FOV: 60 degrees · fundus photo taken with a portable handheld camera:
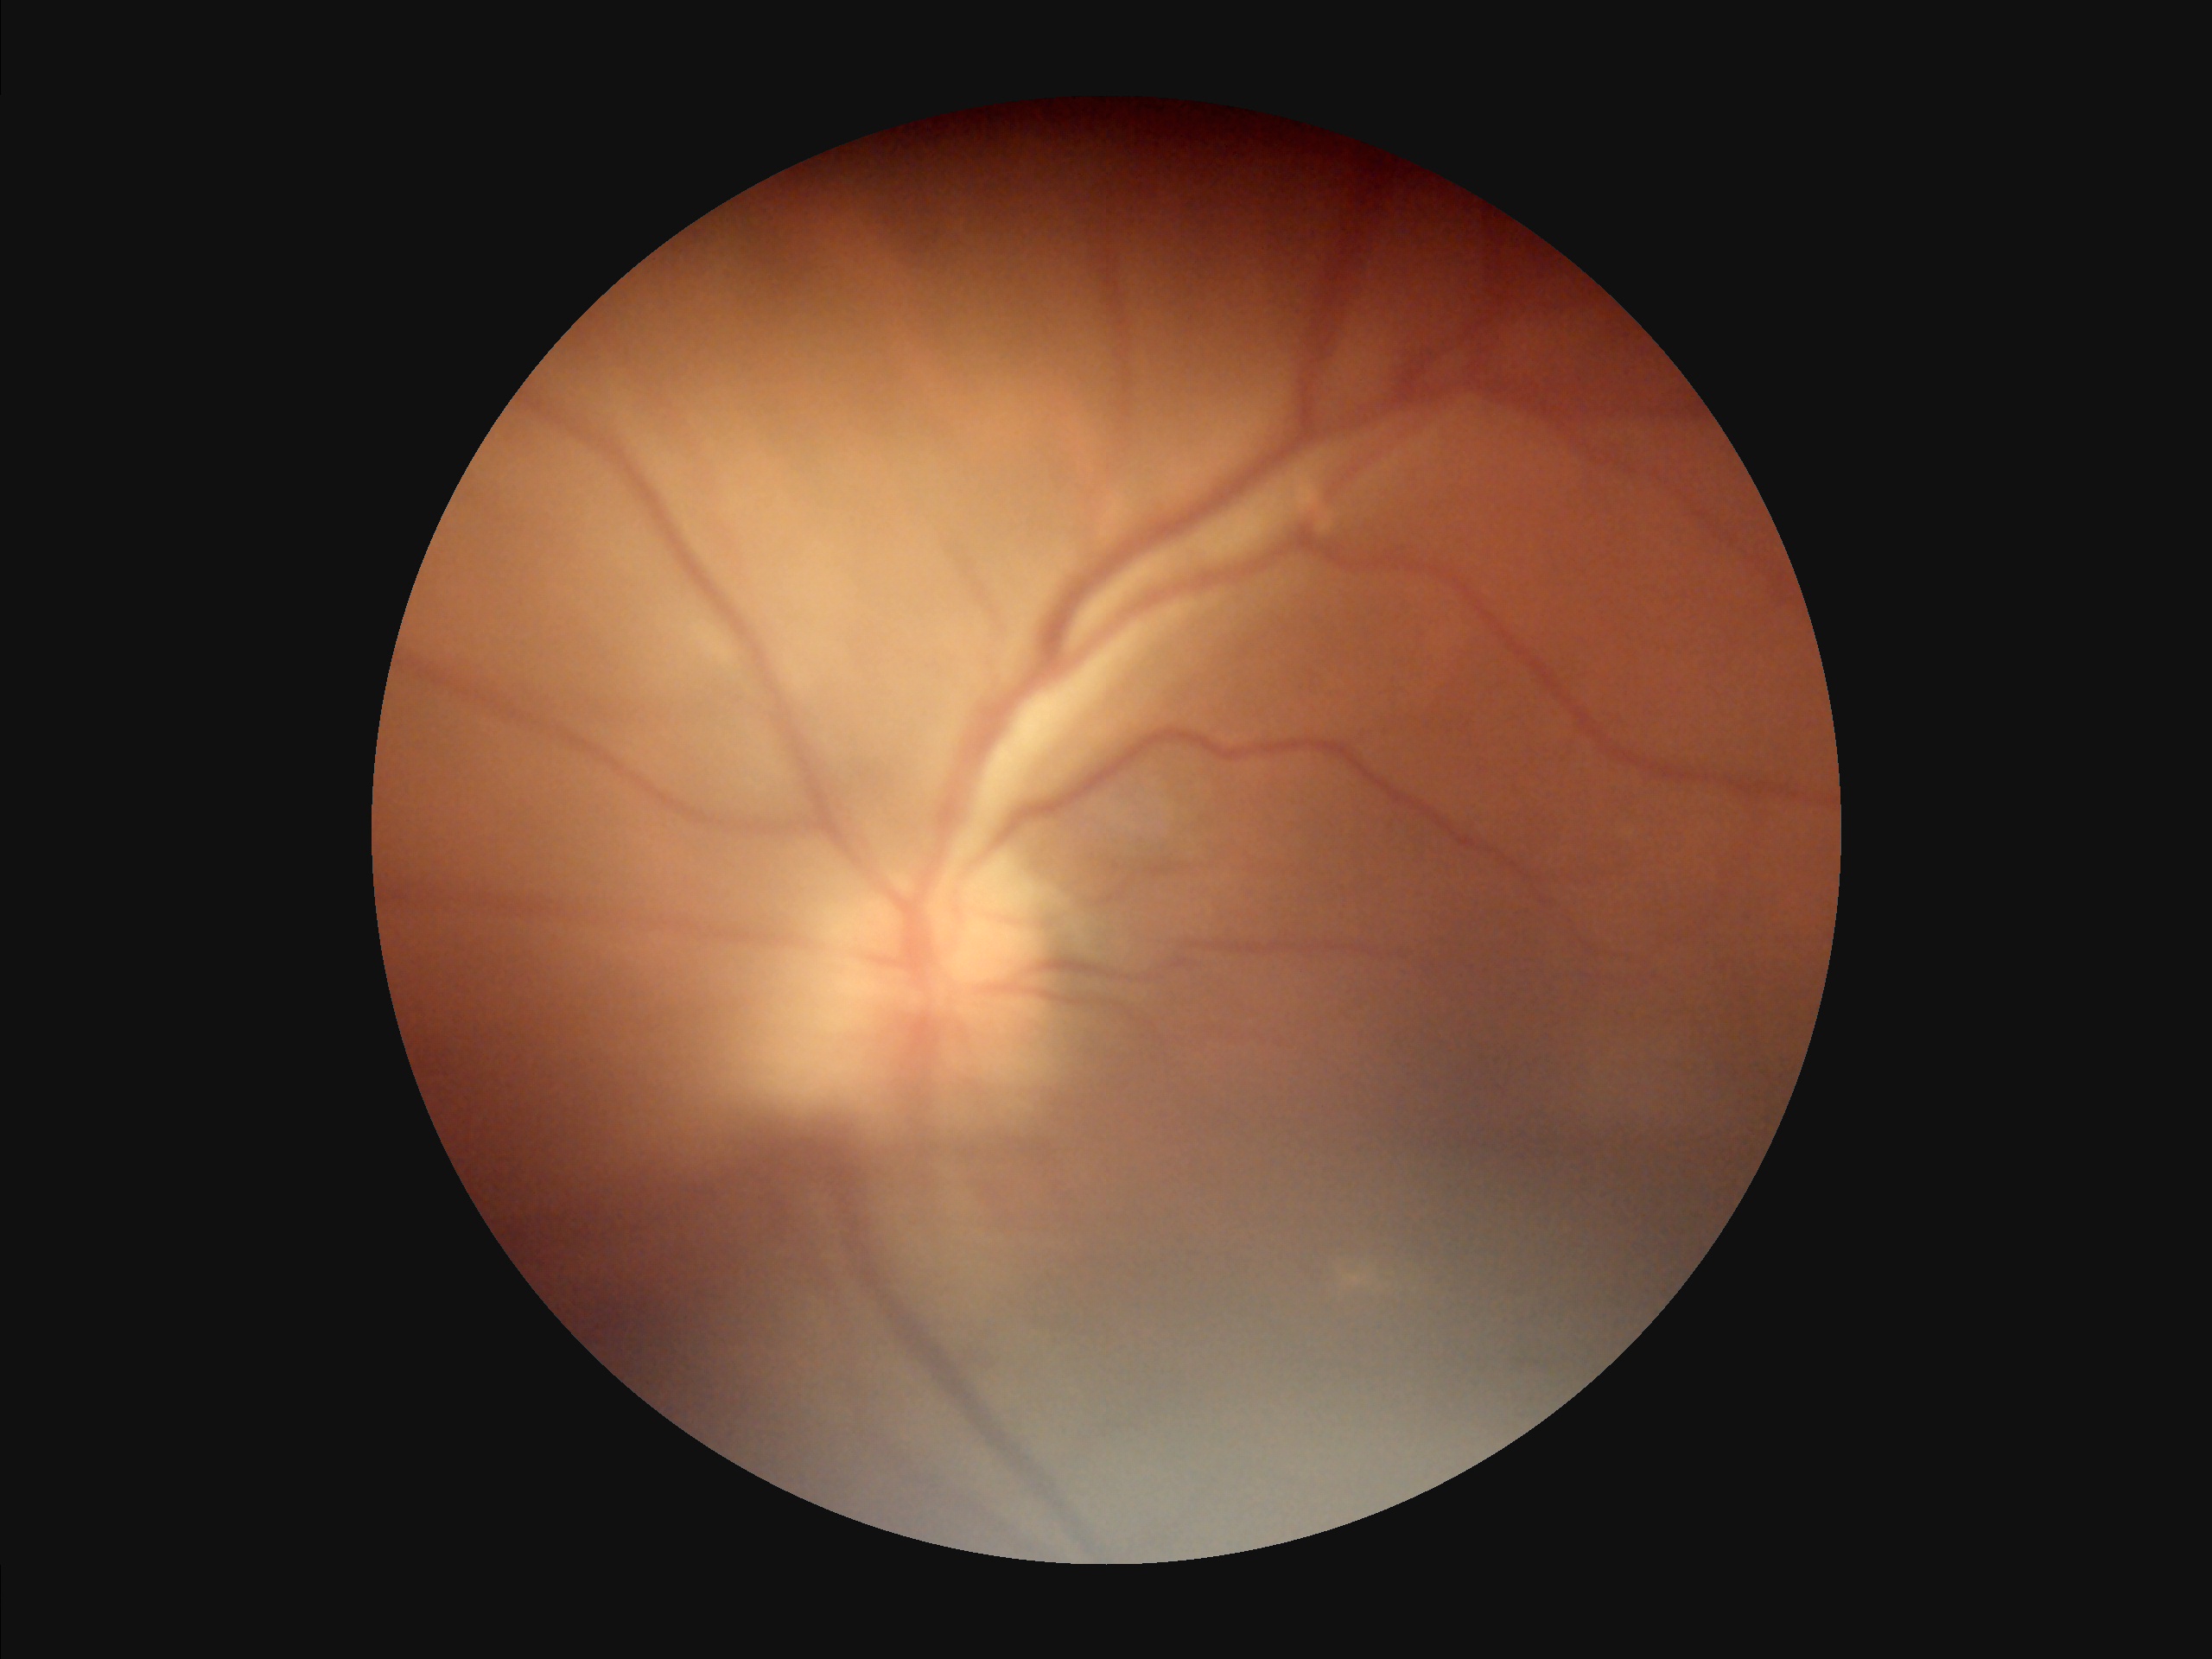

Illumination and color balance are good. Image quality is inadequate for diagnostic use. Noticeable blur in the optic disc, vessels, or background. Contrast is low.